Disc-centered field. 240 by 240 pixels. Color fundus photograph: 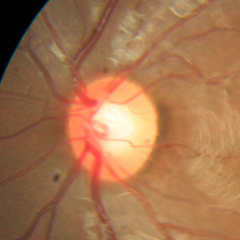 Assessment = no glaucomatous changes.